Captured on a Remidio smartphone fundus camera; image size 1659x2212 — 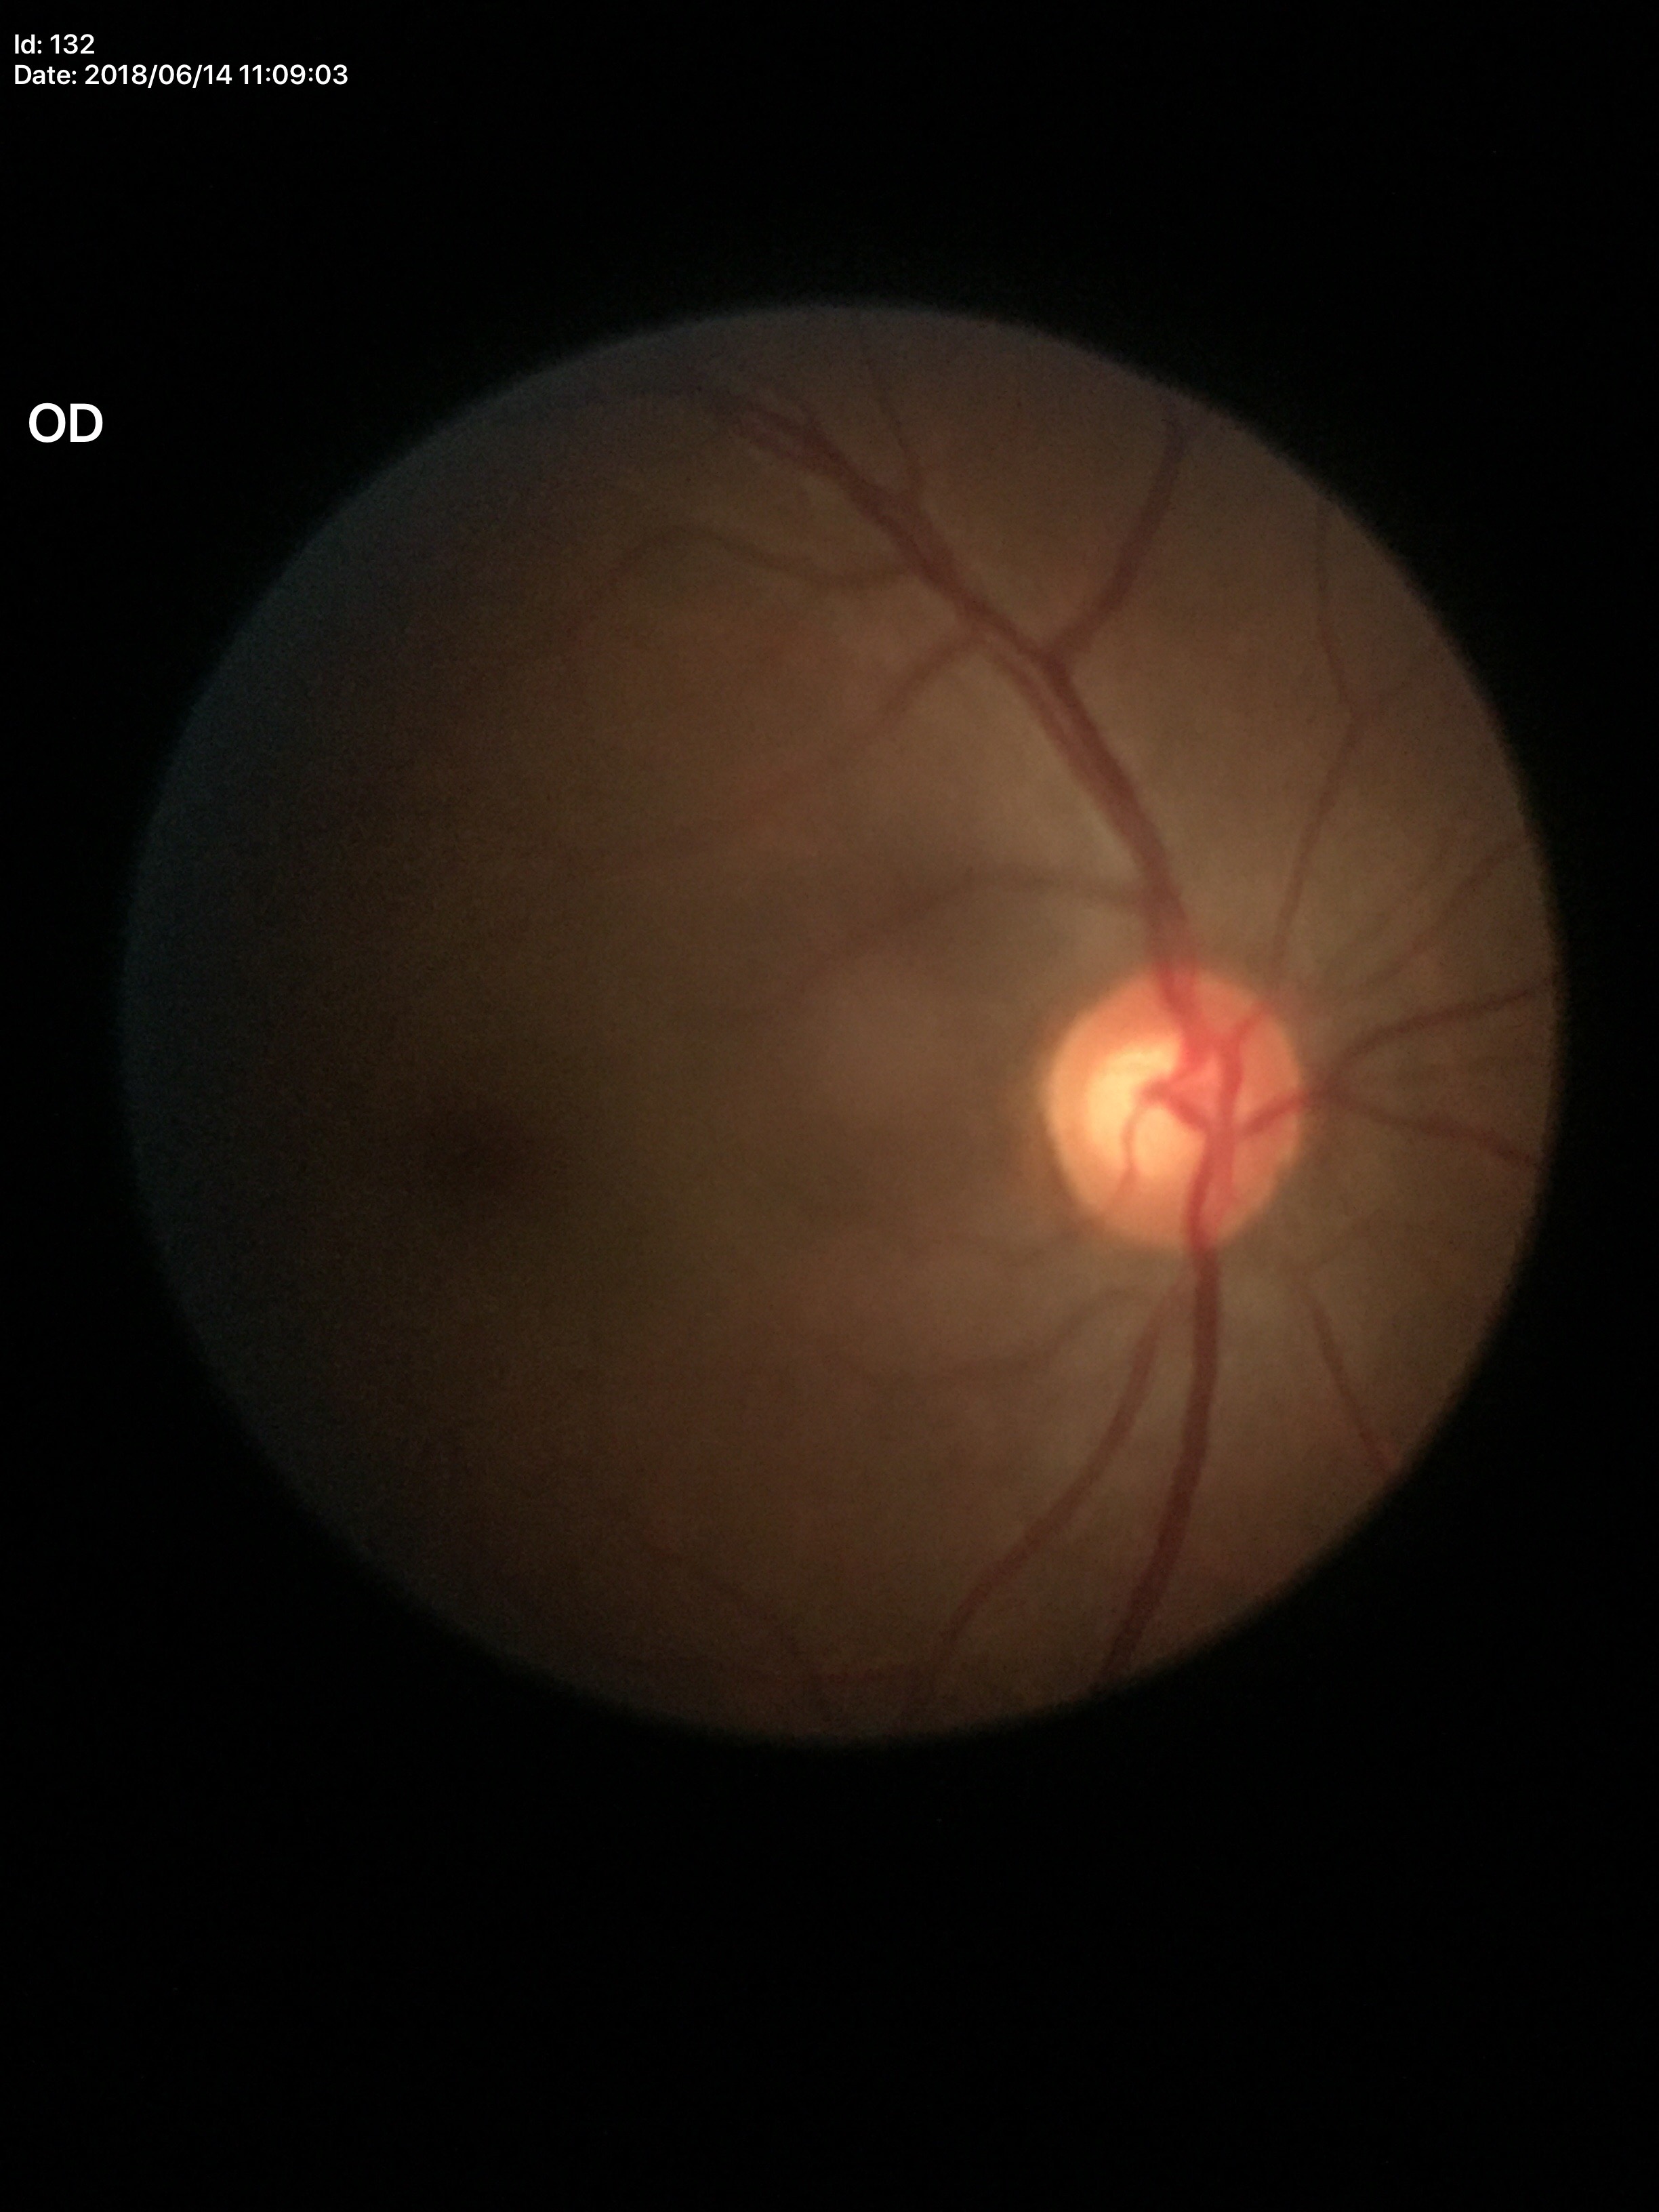
Findings:
• horizontal CDR (HCDR): 0.63
• vertical C/D ratio (VCDR): 0.56
• Glaucoma screening impression: not suspect